45-degree field of view; fundus photo: 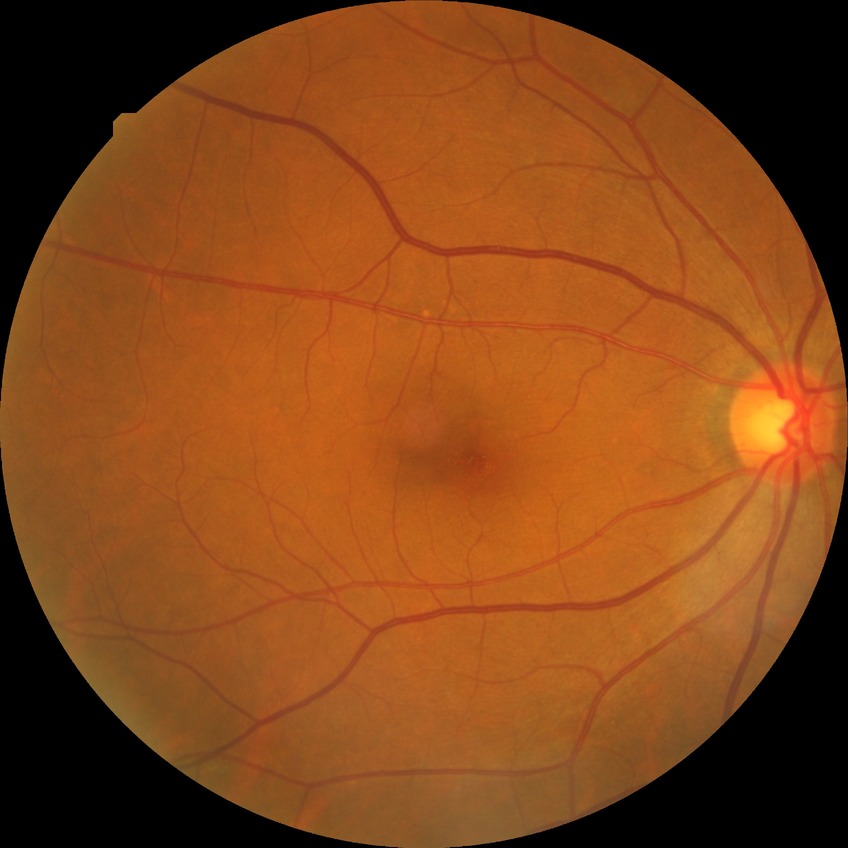

Diabetic retinopathy grade: simple diabetic retinopathy.